No pharmacologic dilation, posterior pole color fundus photograph, 45° field of view
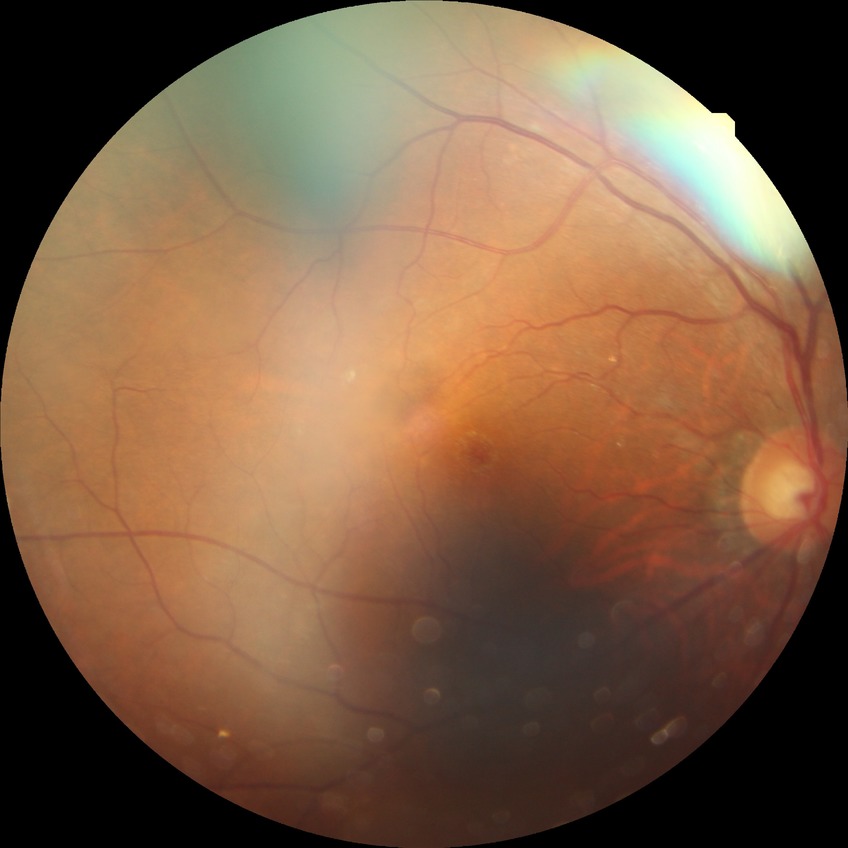
DR class: non-proliferative diabetic retinopathy.
DR stage is SDR.